50° field of view, posterior pole field covering the optic disc and macula:
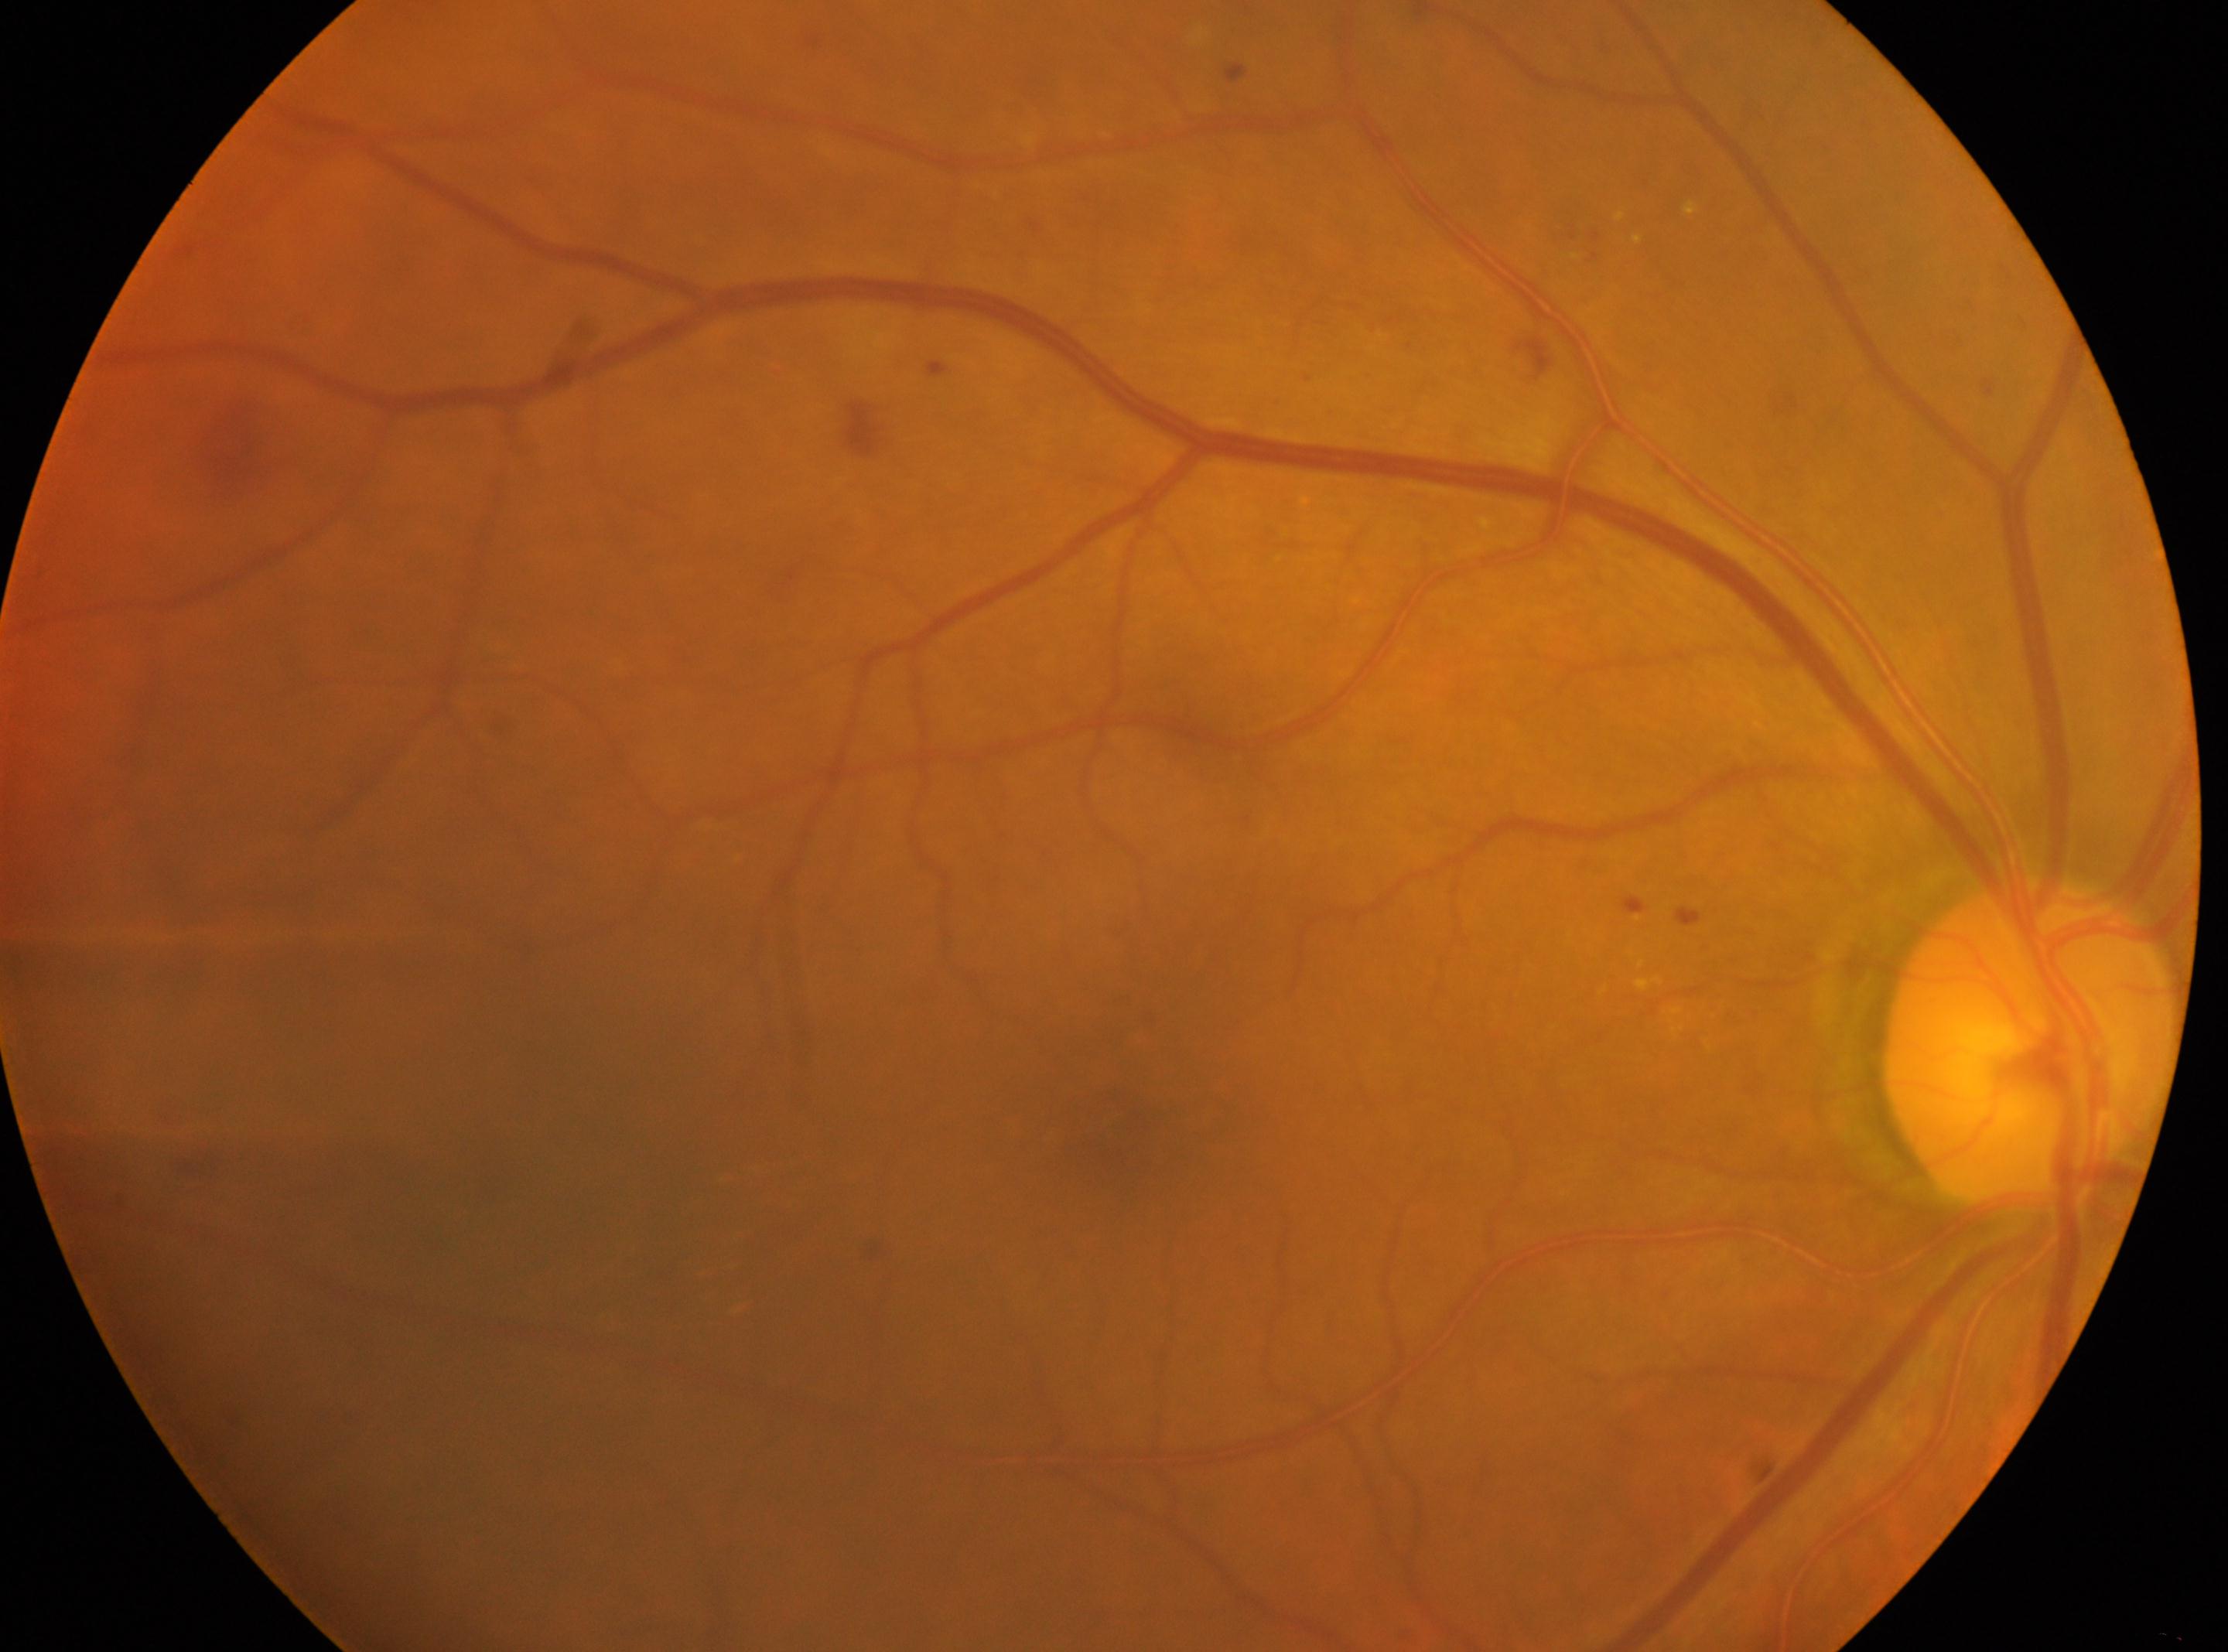

DR class: non-proliferative diabetic retinopathy
eye: OD
ONH: 2030, 1046
macula center: 1122, 1131
DR: 2 — more than just microaneurysms but less than severe NPDR